2352 by 1568 pixels — 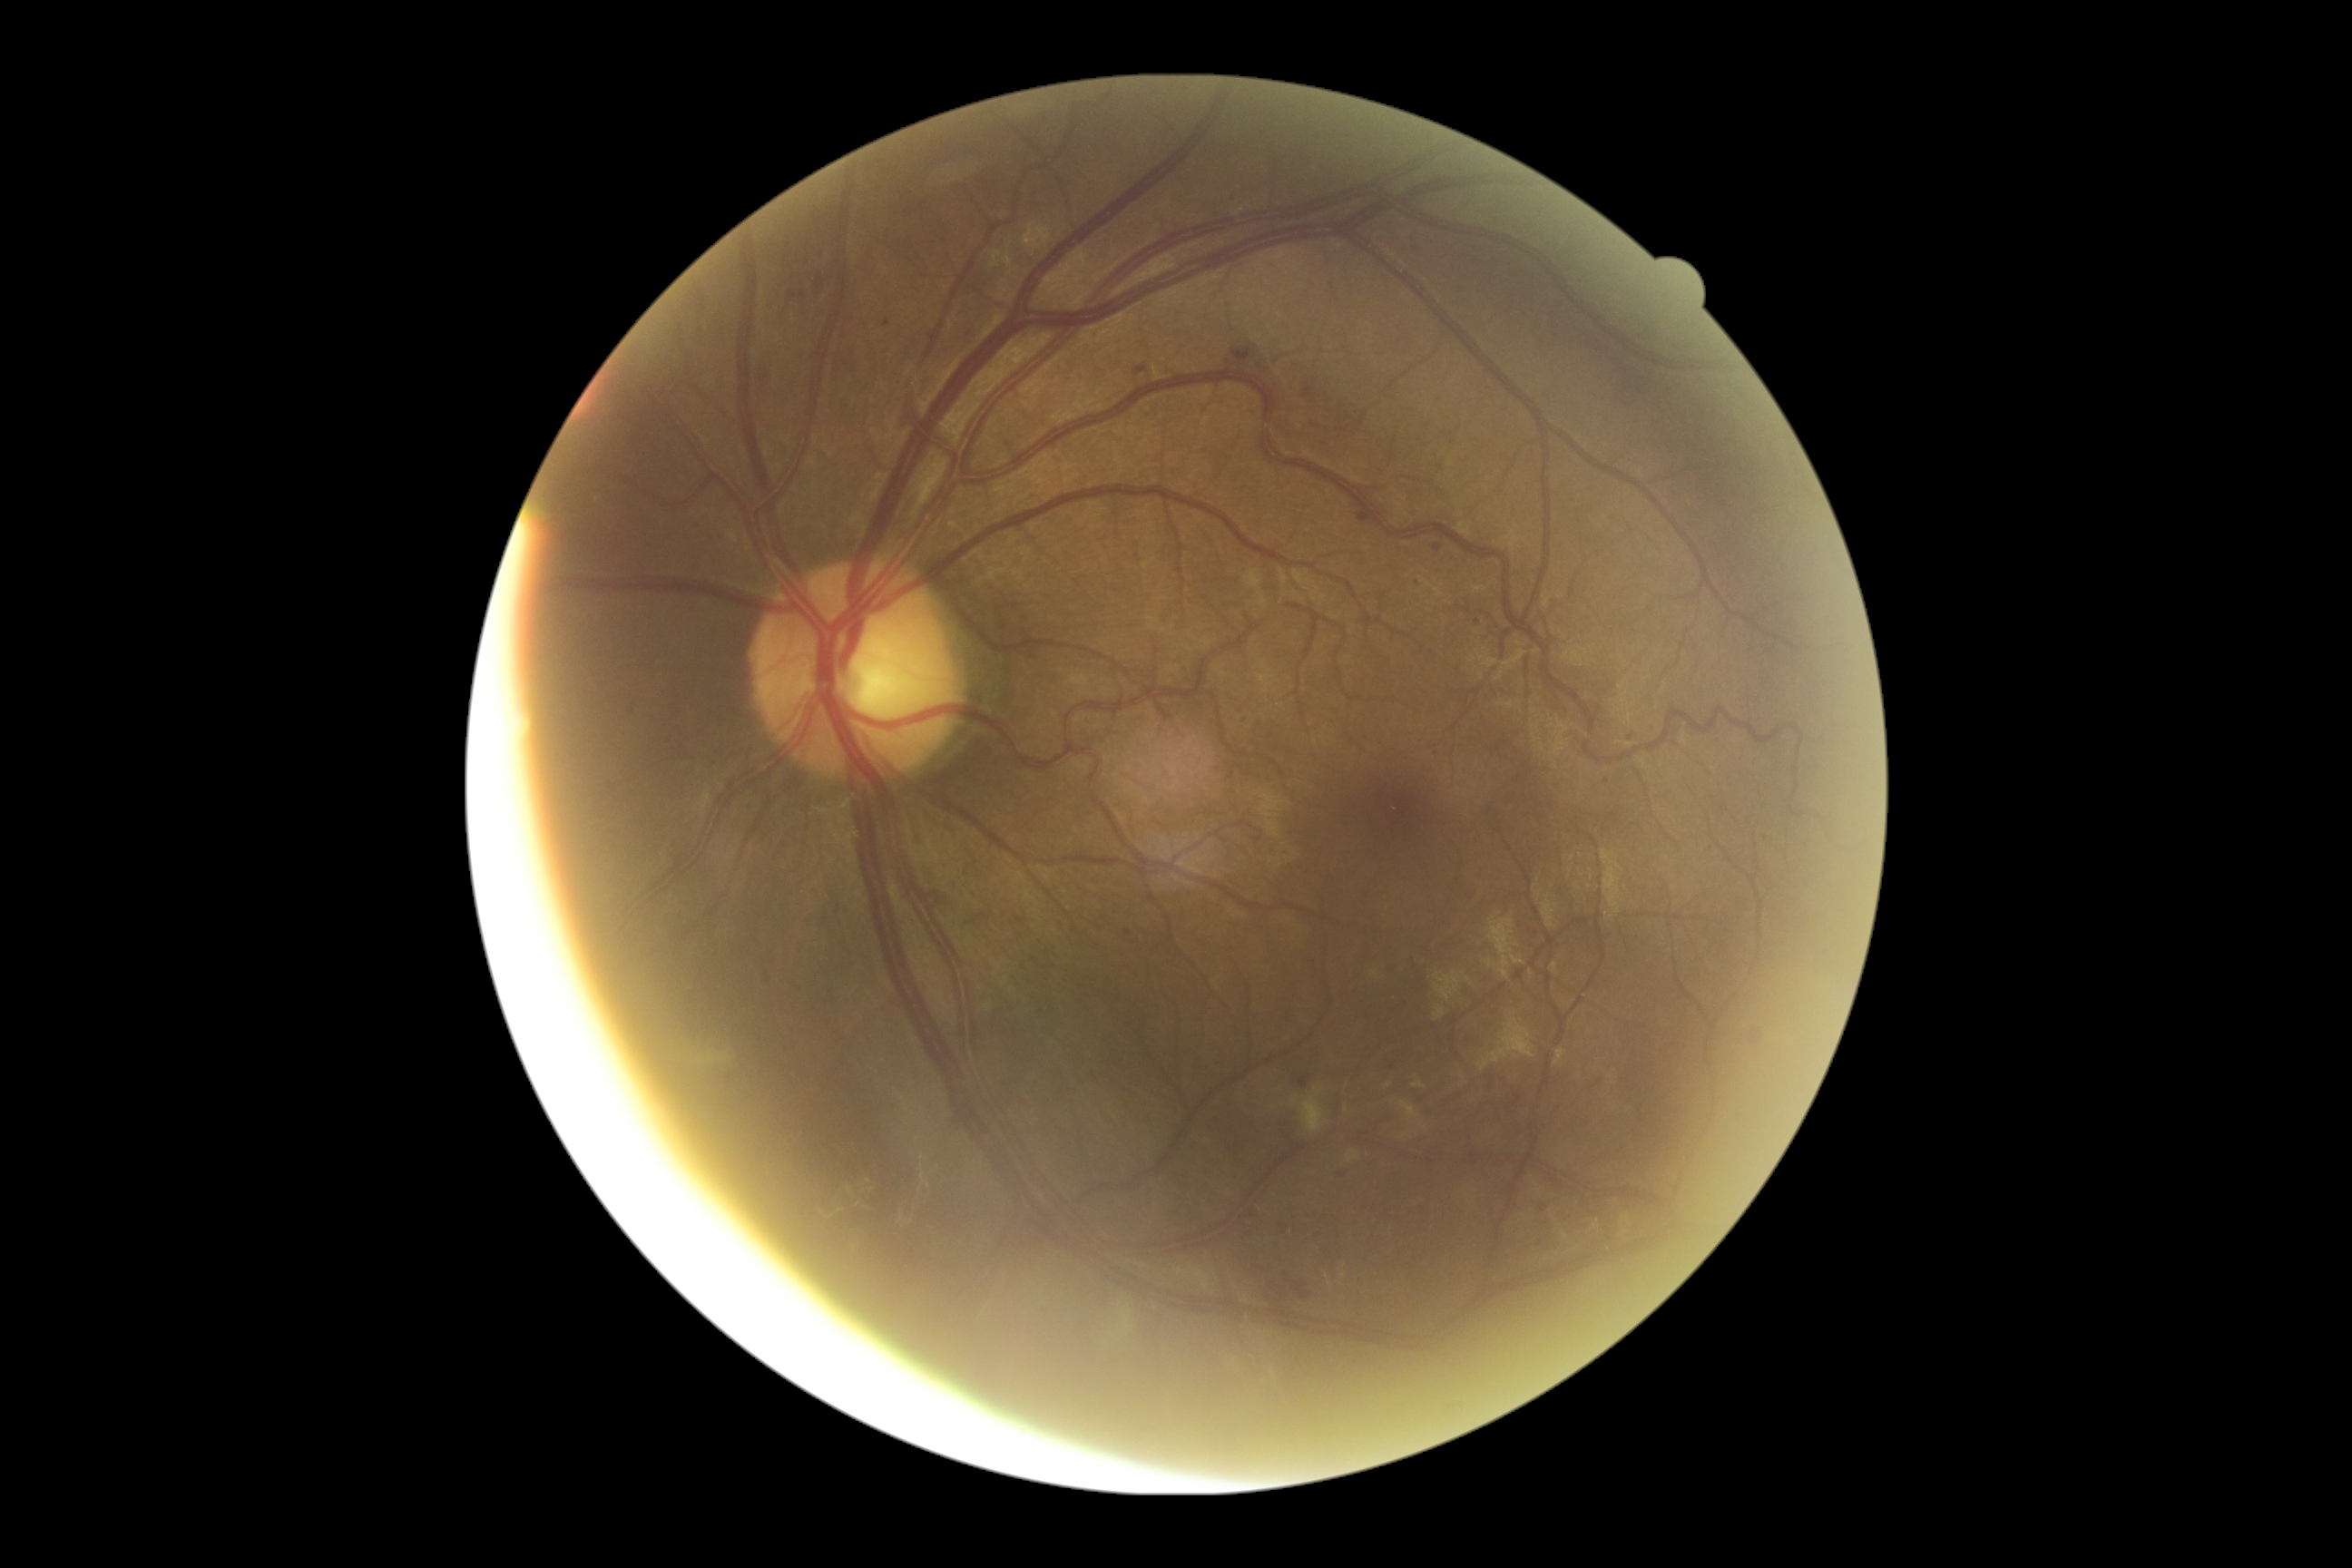
DR class@non-proliferative diabetic retinopathy; retinopathy grade@moderate NPDR (2).